848x848: 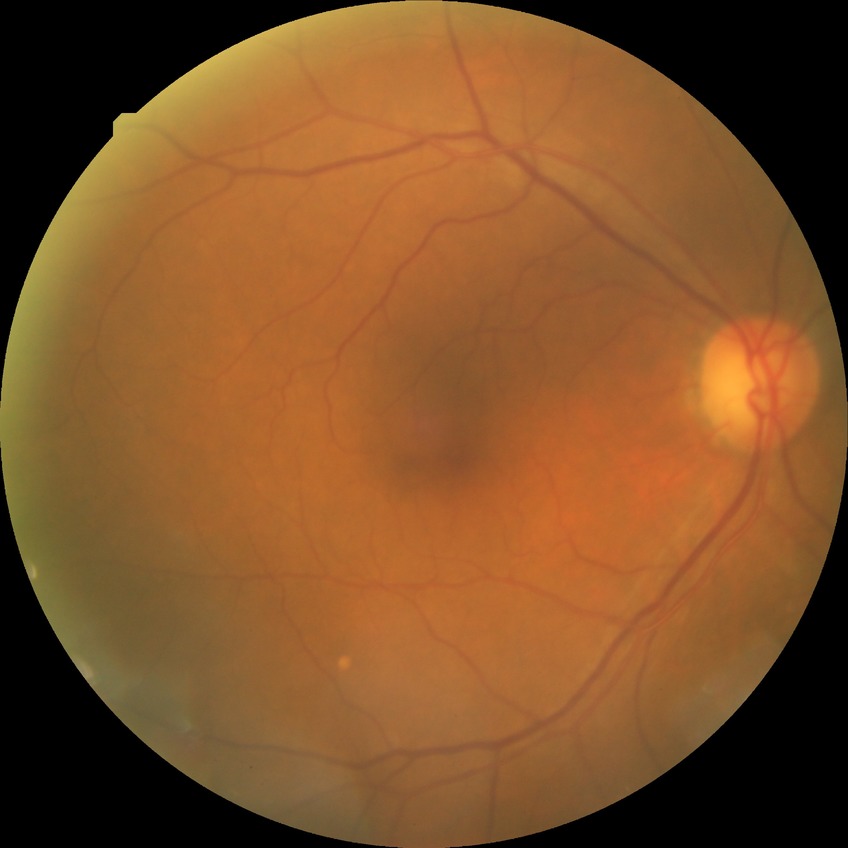
Modified Davis classification: no diabetic retinopathy.